45° FOV. Fundus photo
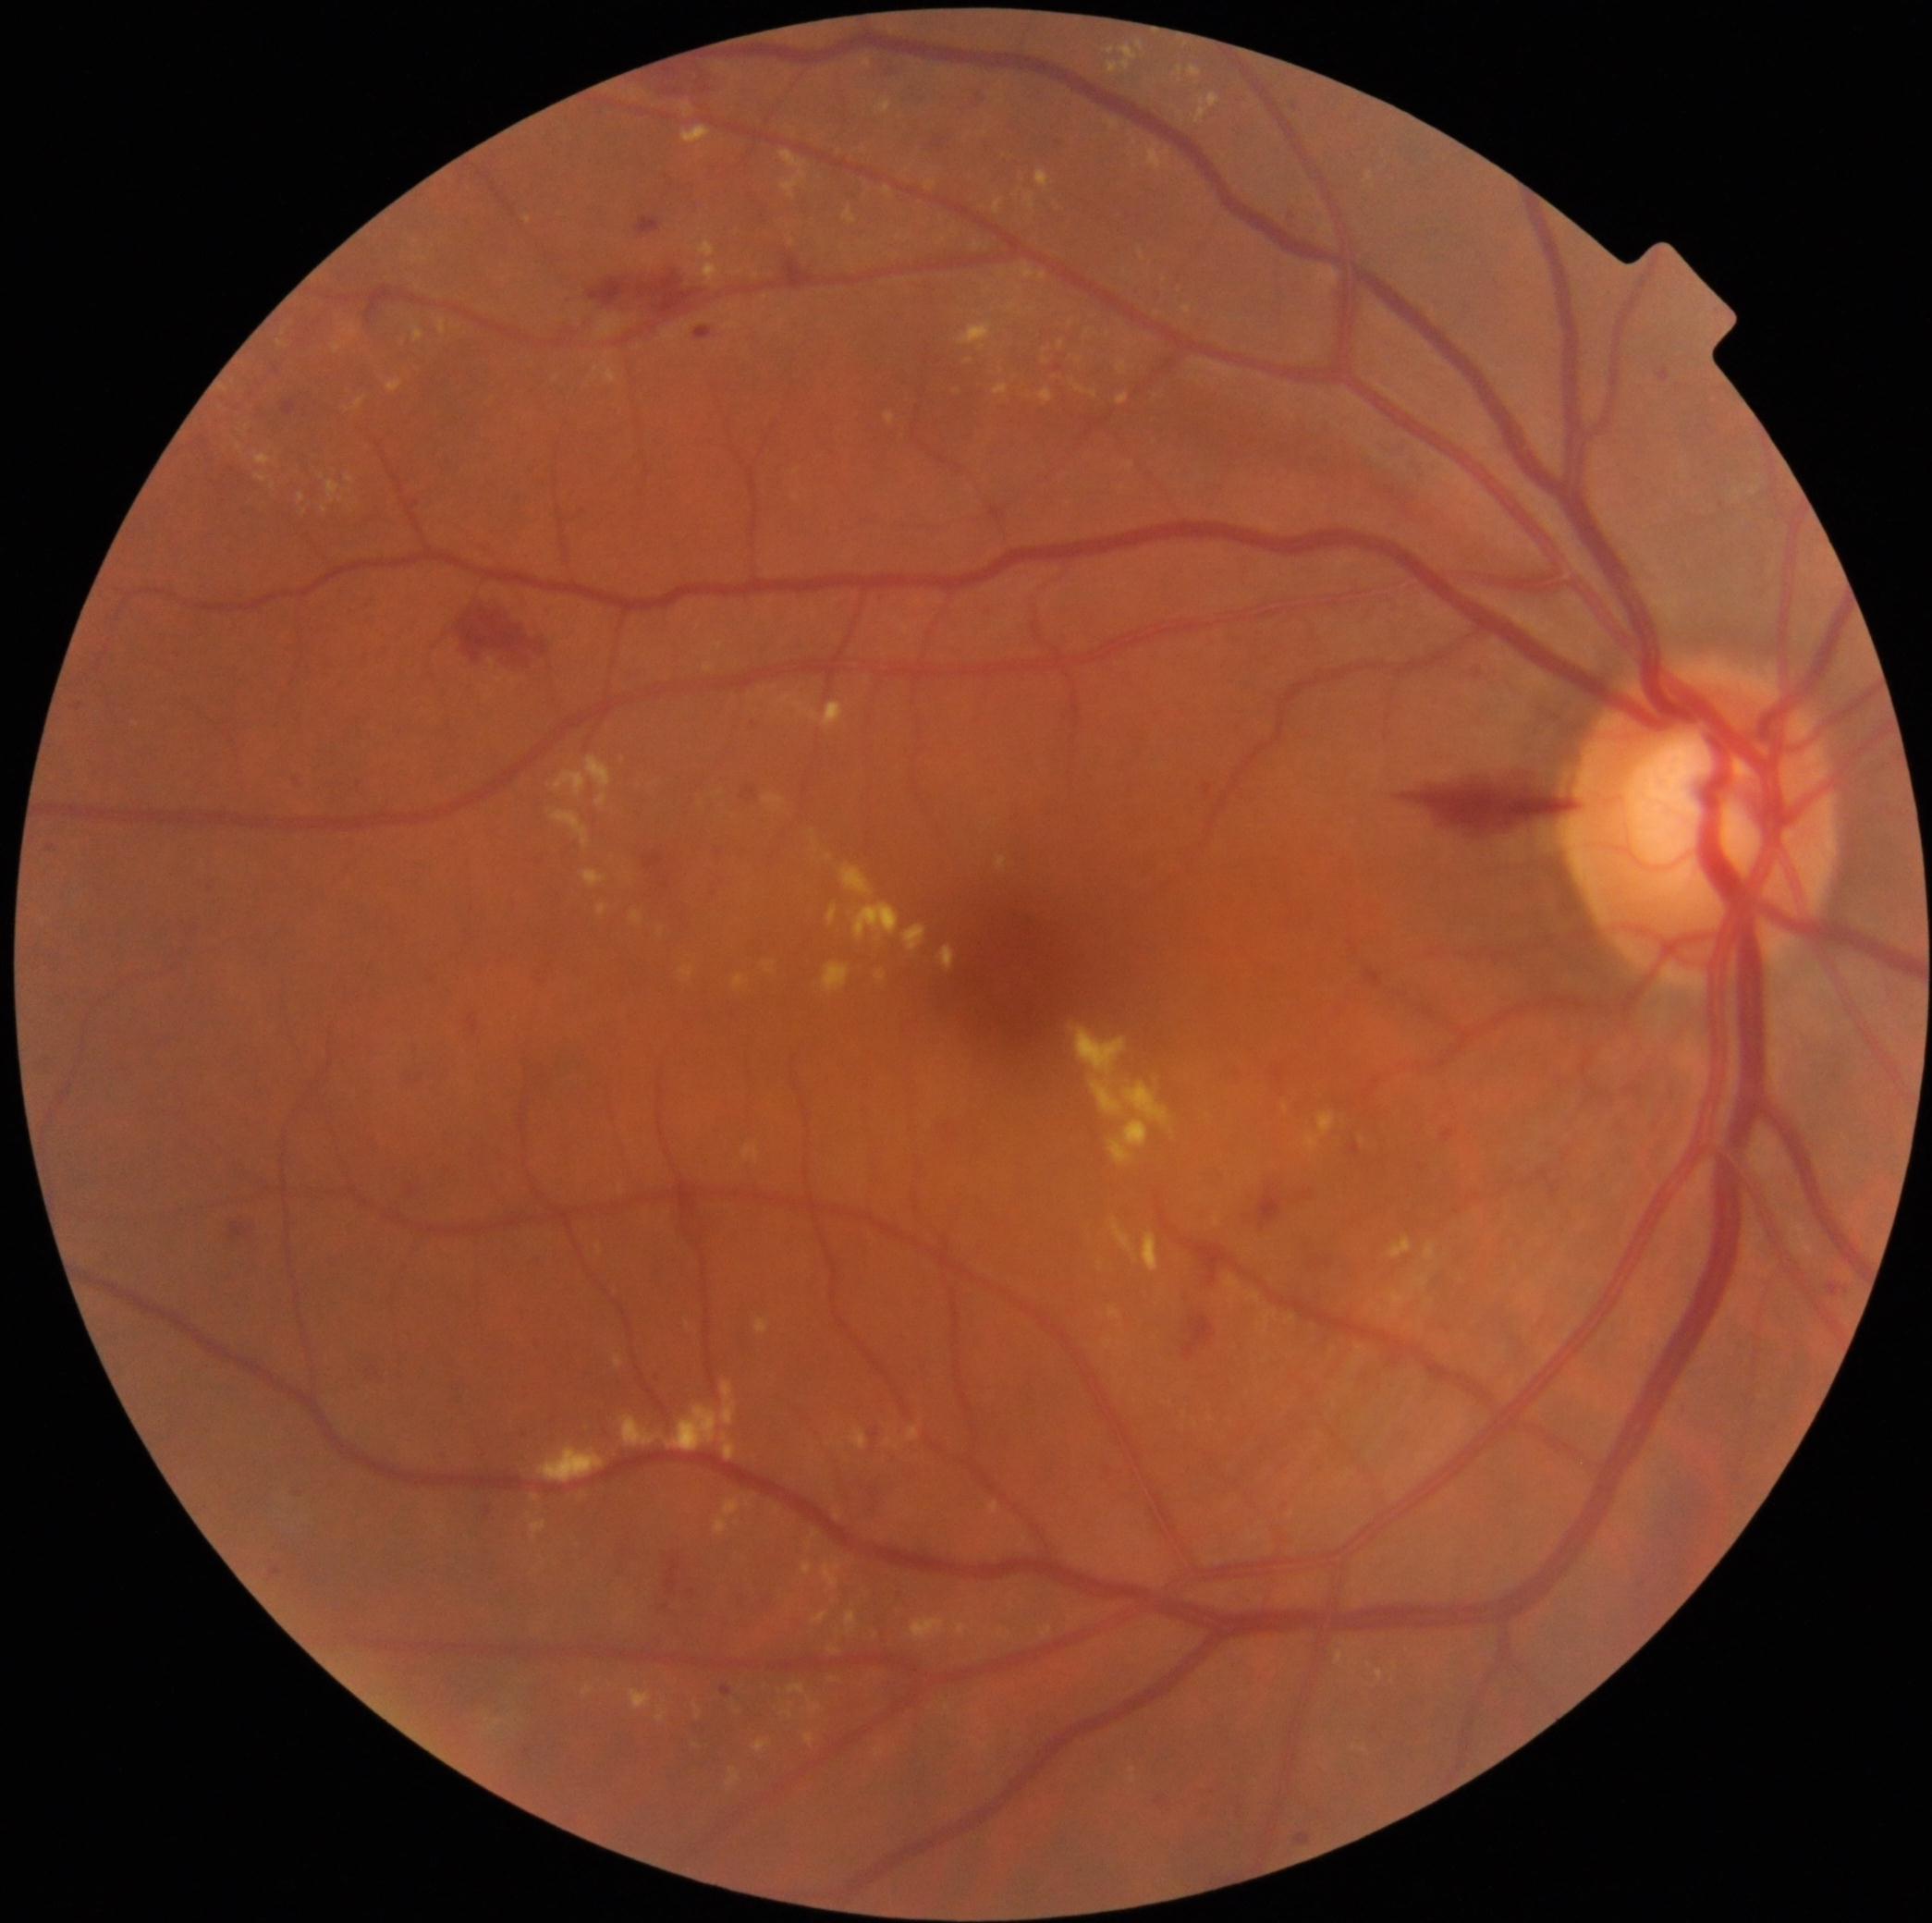

<lesions partial="true">
  <dr_grade>2</dr_grade>
  <ex partial="true">1353/1642/1363/1646 | 864/59/872/68 | 1125/461/1136/472 | 1021/264/1034/280 | 755/1318/771/1333 | 846/1611/859/1635 | 883/188/892/198 | 1143/1232/1160/1272 | 538/1446/605/1483 | 1248/1292/1262/1304 | 975/244/983/250 | 632/911/643/925 | 742/1141/762/1163 | 840/864/874/898</ex>
  <ex_small_centers>1291, 1318 | 1346, 1642 | 737, 1523 | 766, 298 | 1020, 290</ex_small_centers>
</lesions>